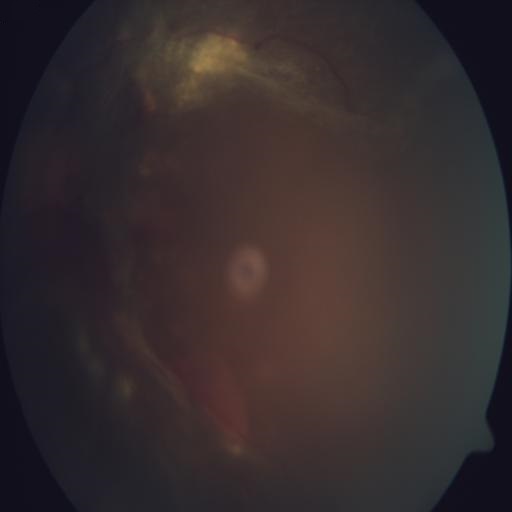

Diagnosis:
- retinitis (RS)